Image size 2228x1652. 50° field of view — 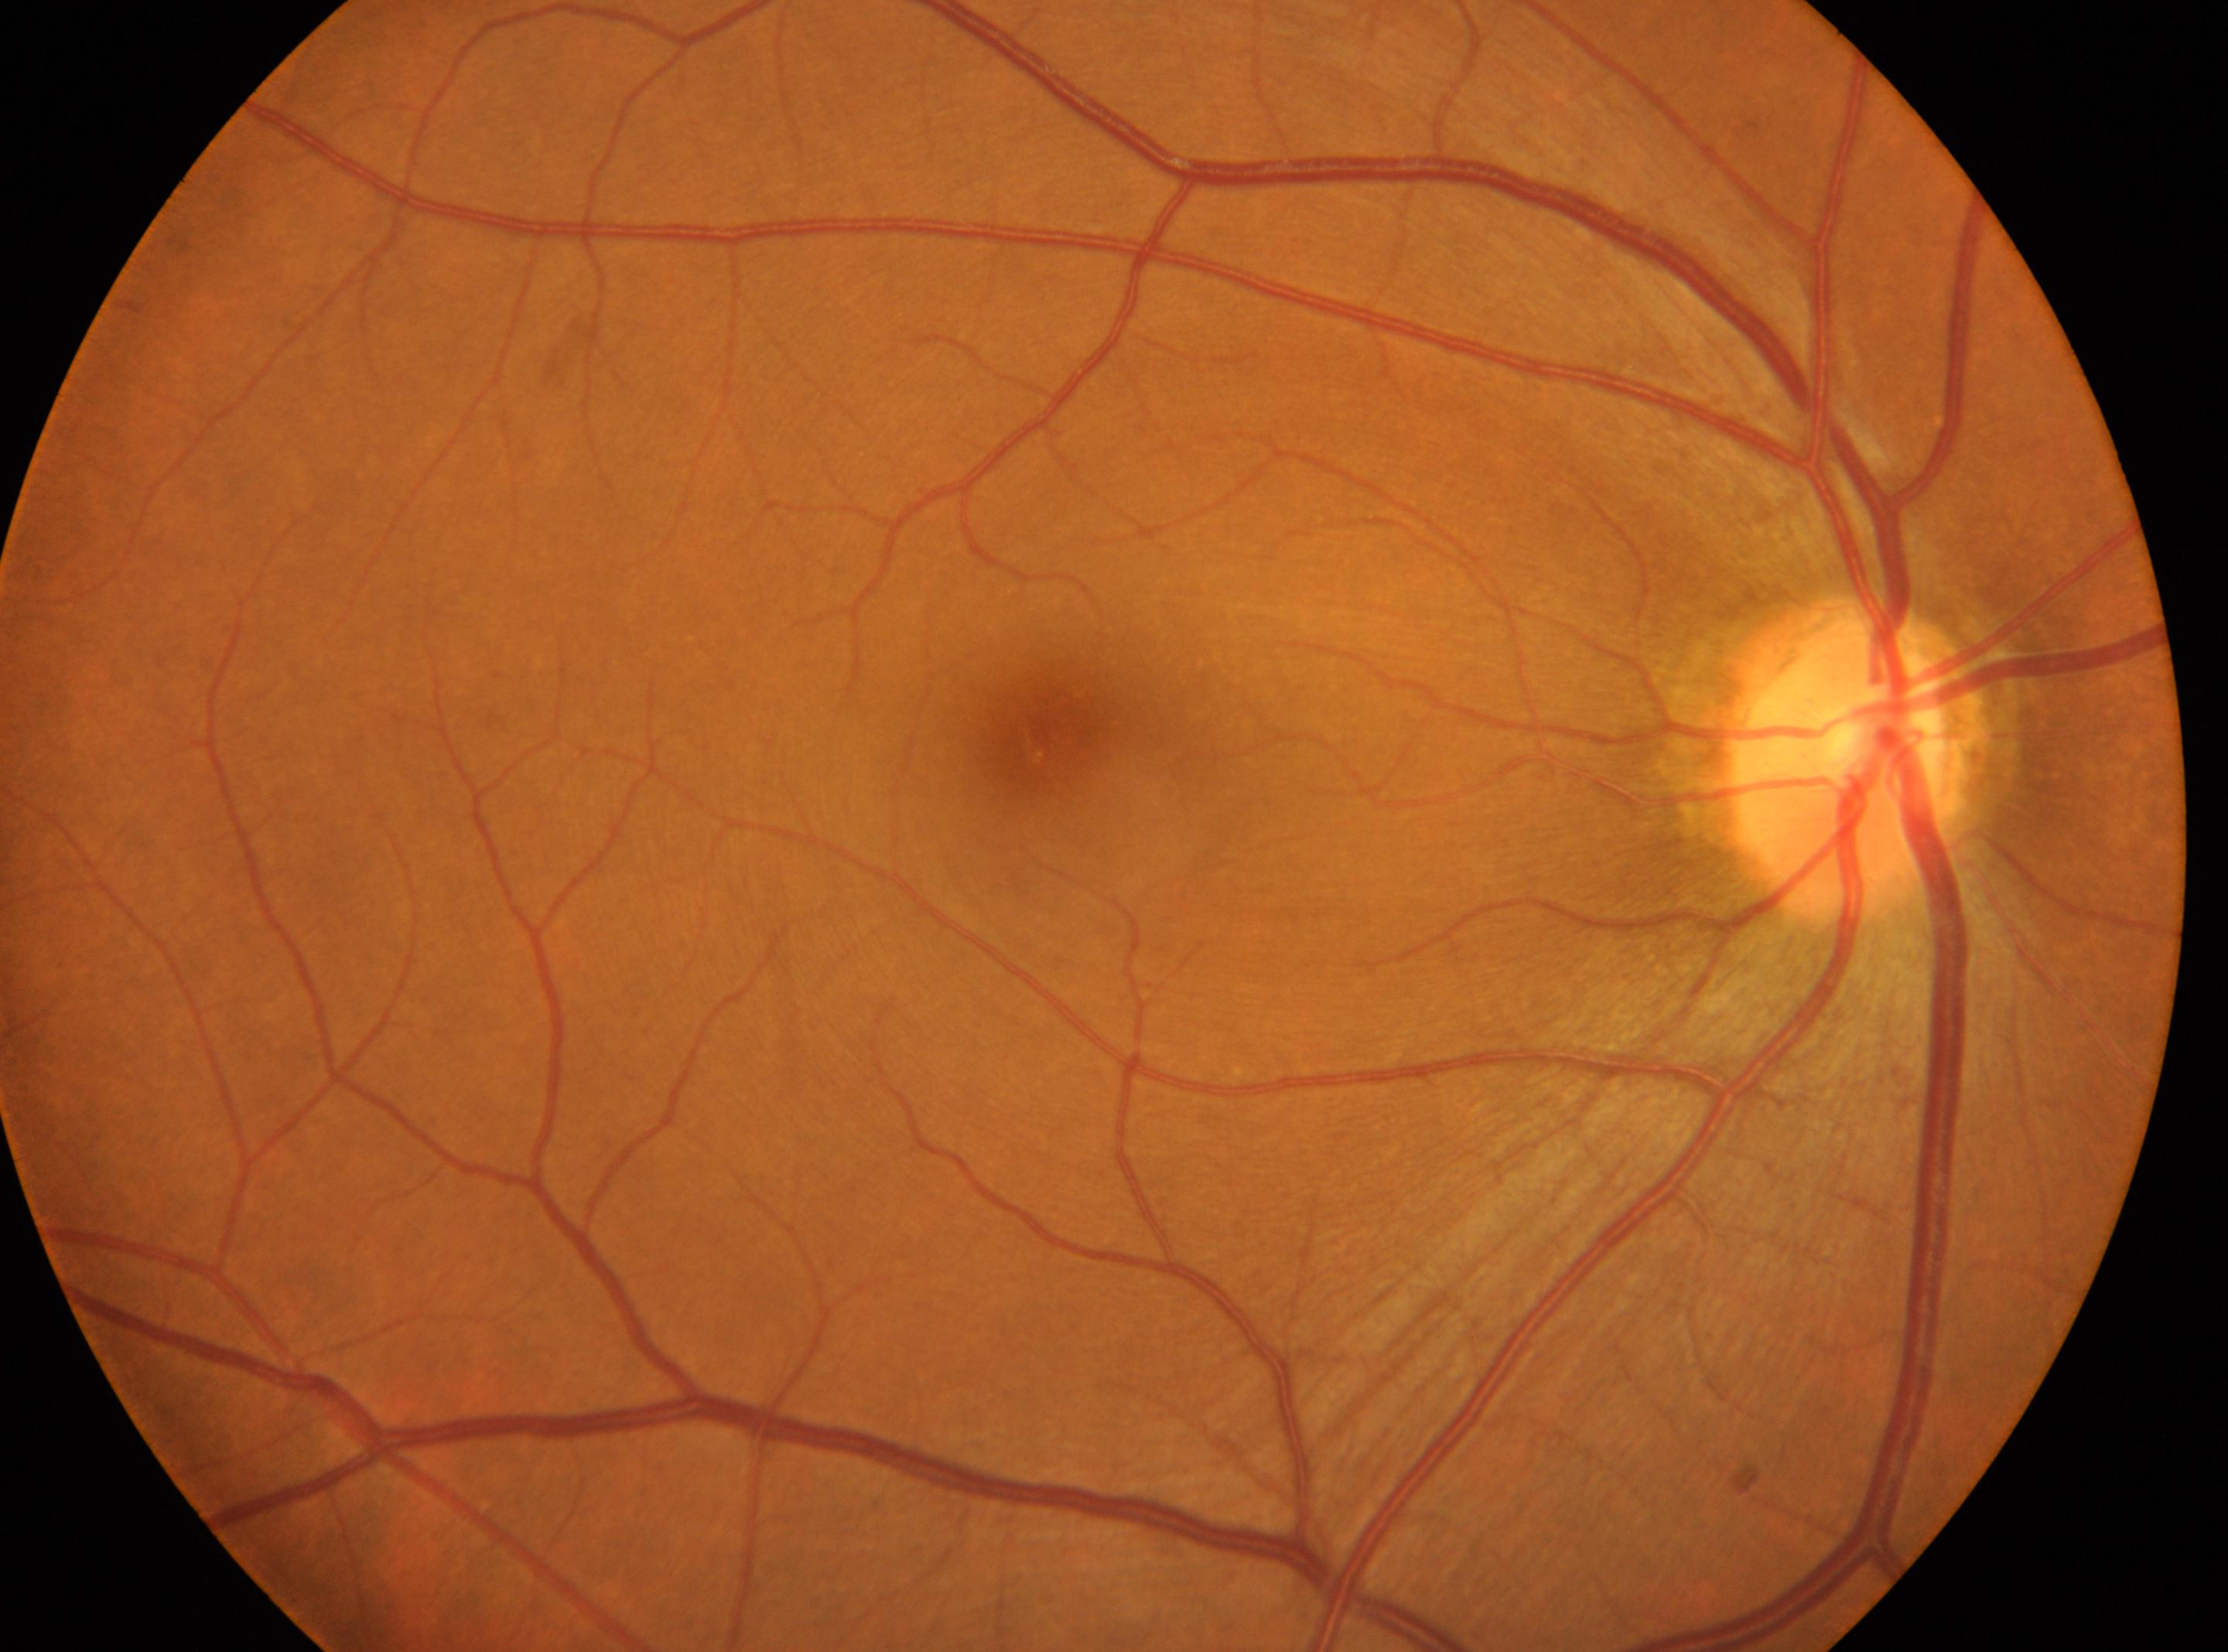

  dr_grade: no apparent retinopathy (grade 0)
  fovea: 1040px, 741px
  eye: right
  optic_disc: 1848px, 770px